Davis DR grading: 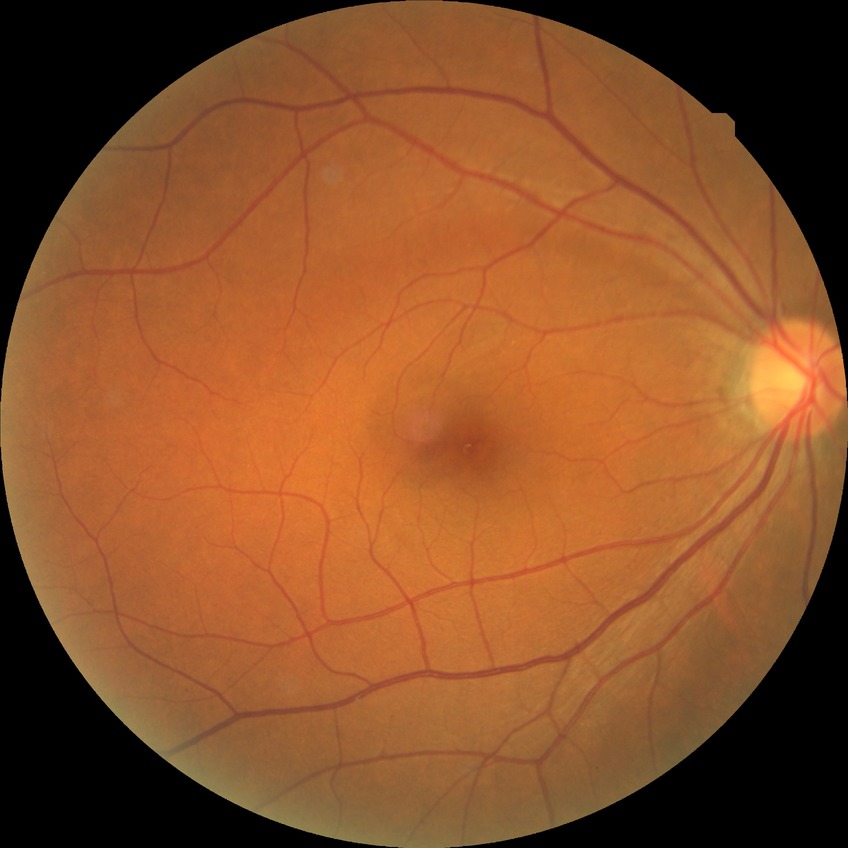

retinopathy stage = no diabetic retinopathy.